Color fundus image. 45° FOV: 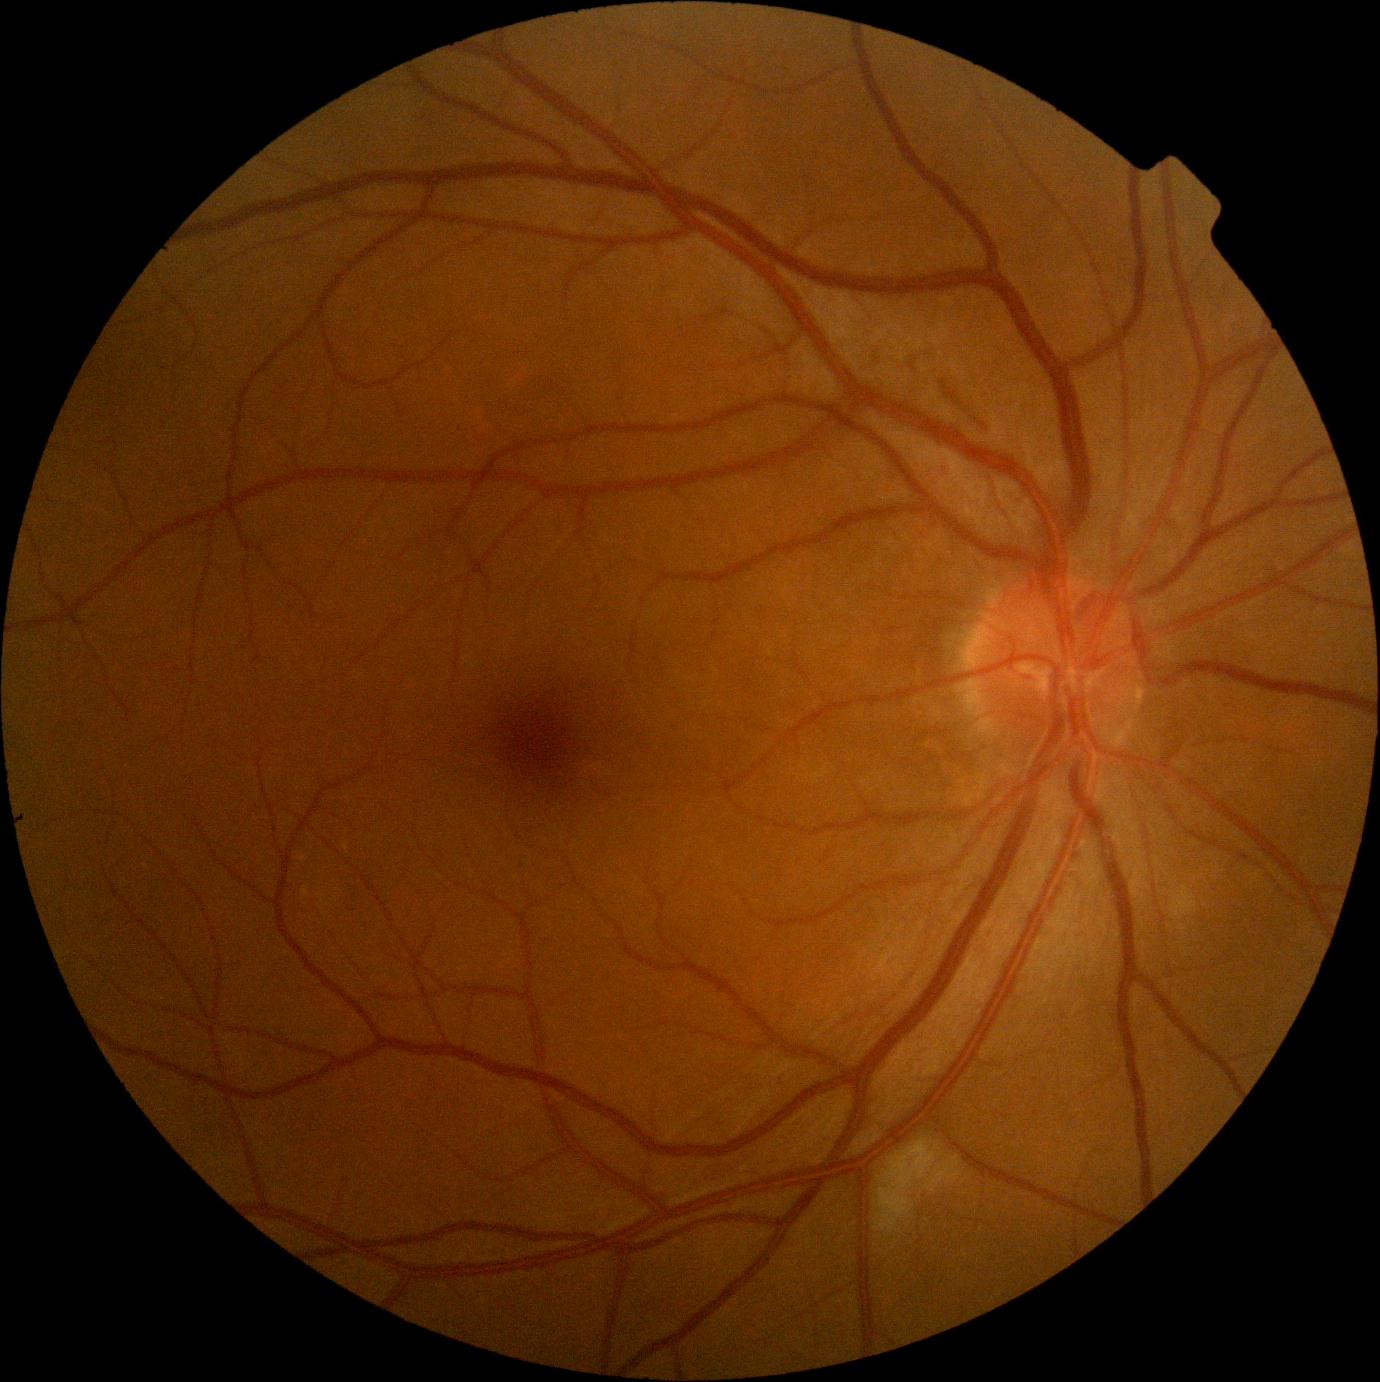

DR severity: moderate NPDR (grade 2).